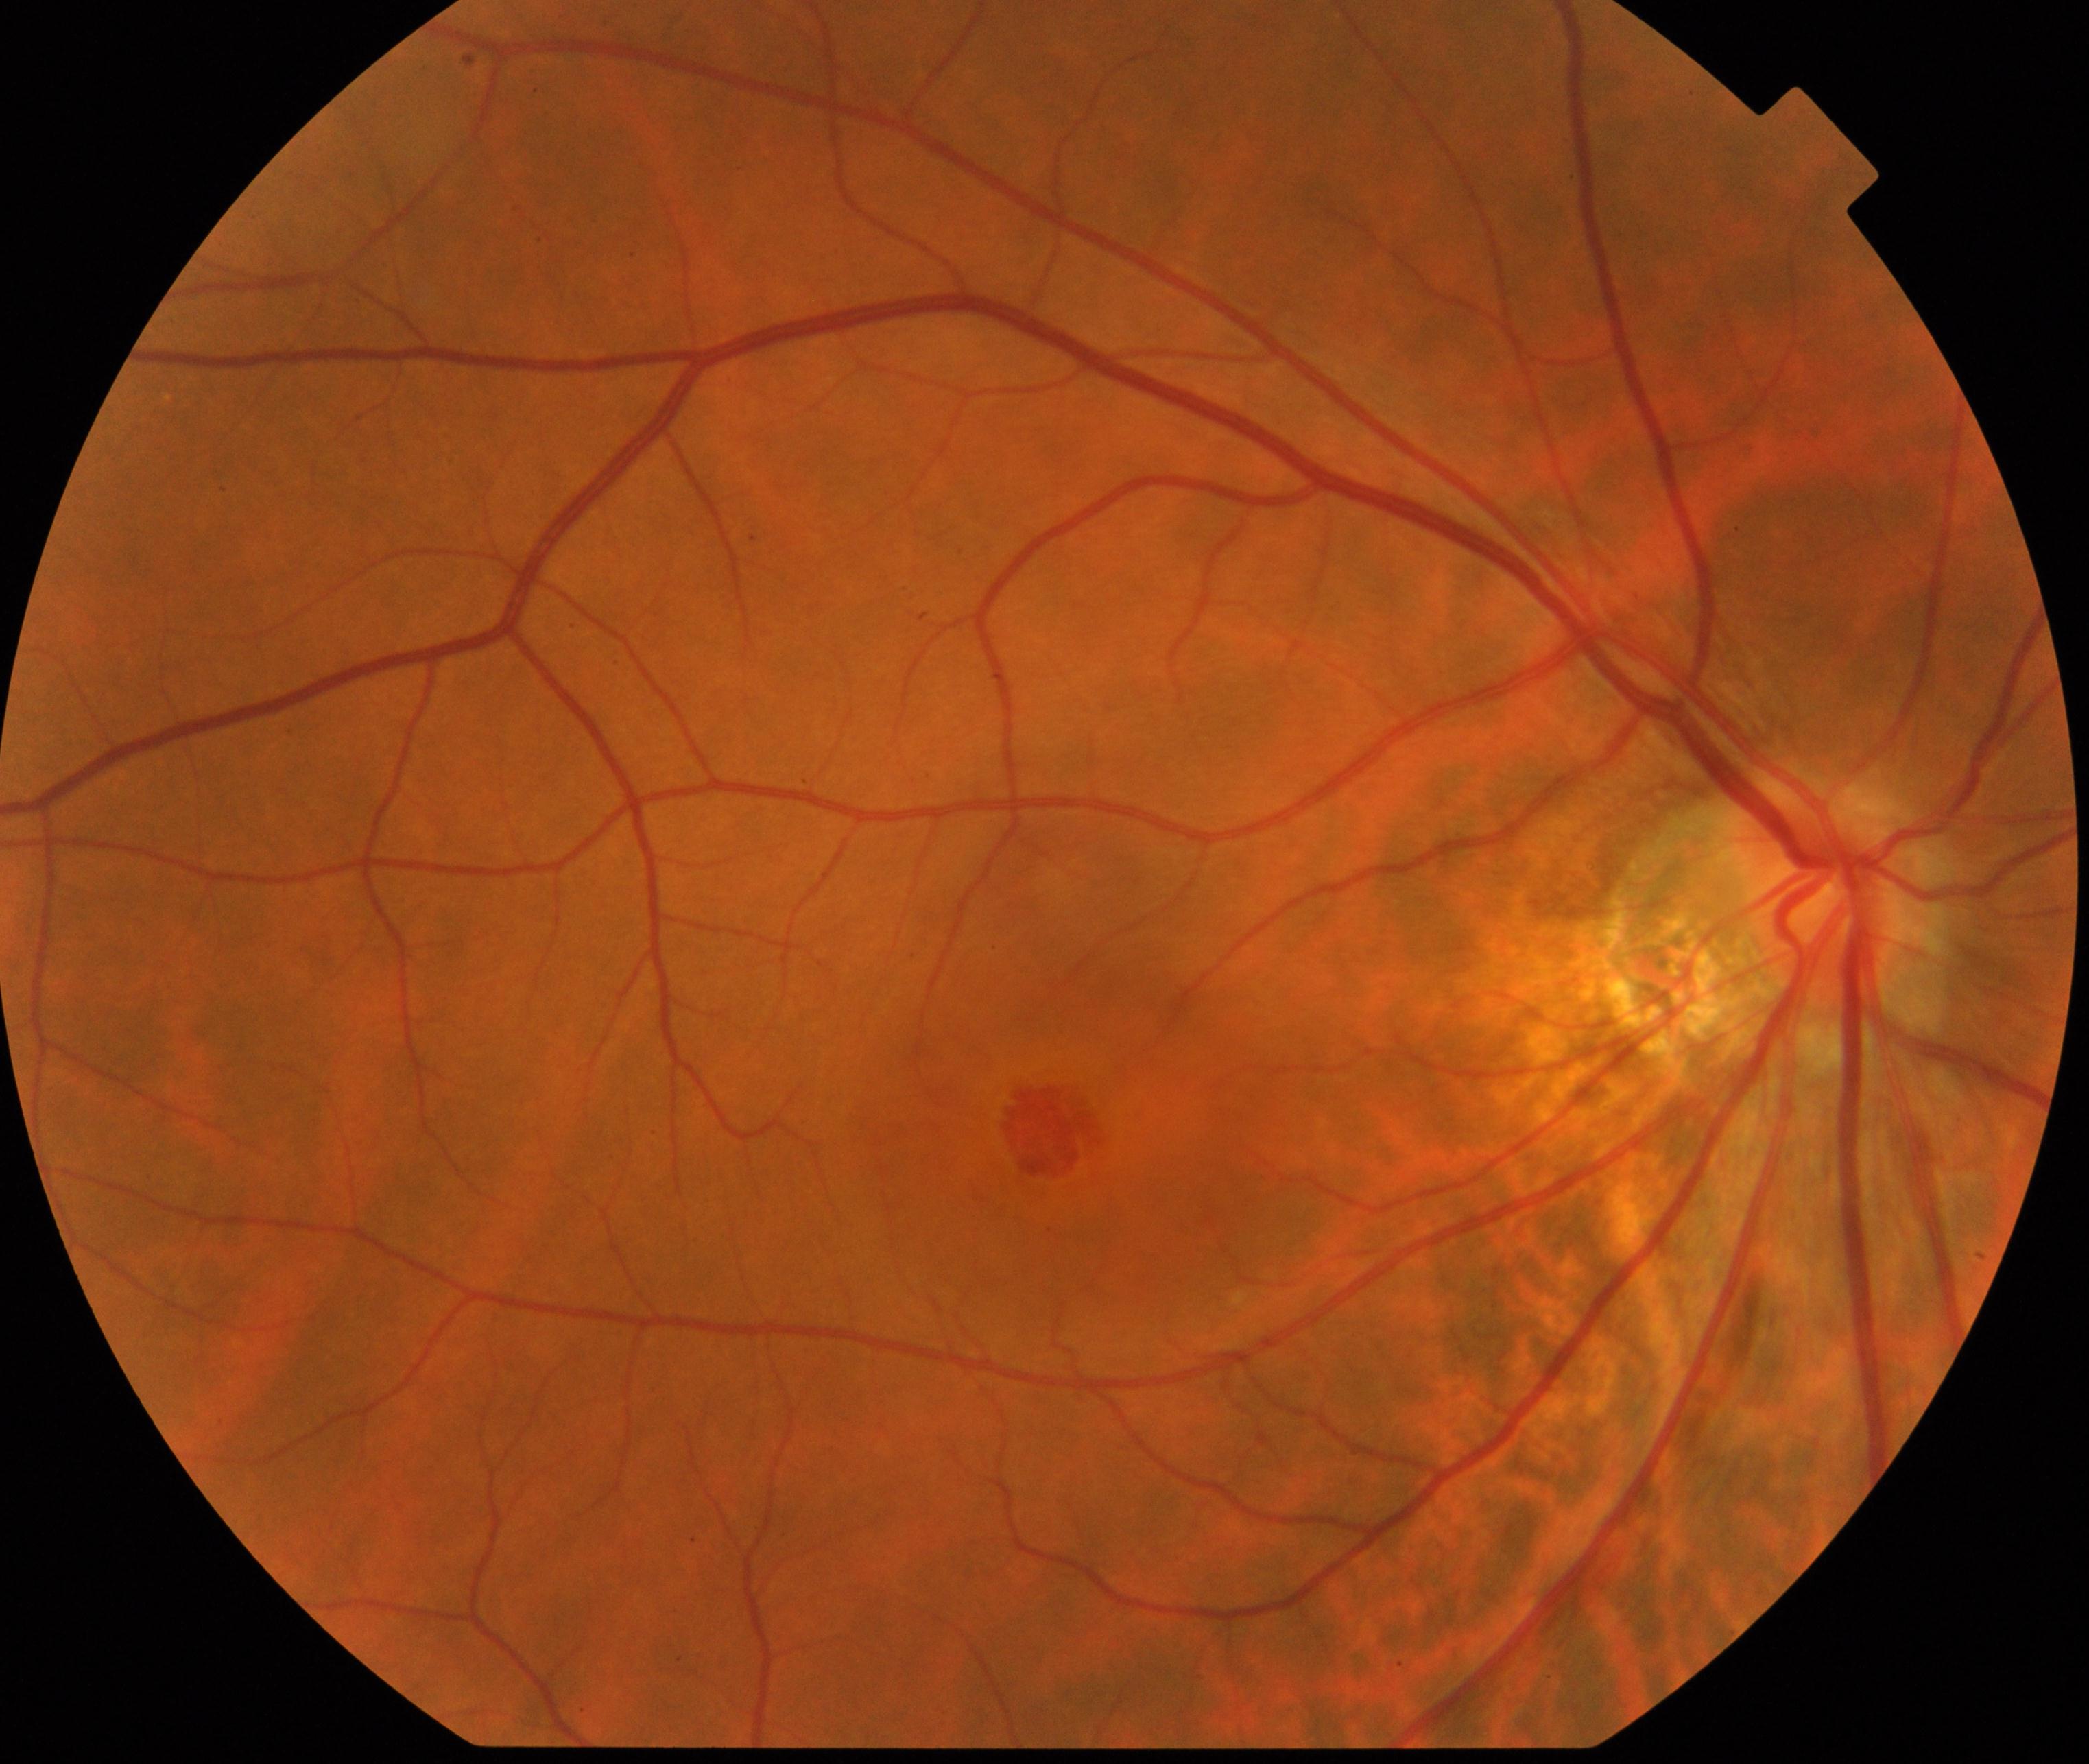

Fundus image consistent with macular hole (MH).